No pharmacologic dilation; 848 by 848 pixels — 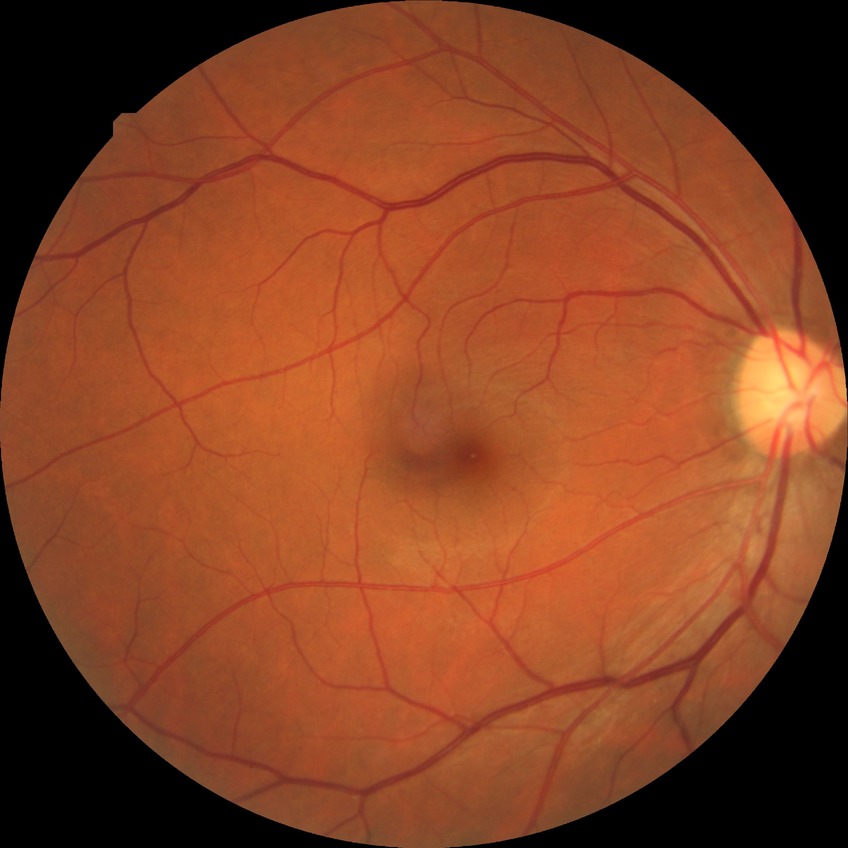

Diabetic retinopathy (DR): NDR (no diabetic retinopathy).